1960 x 1897 pixels.
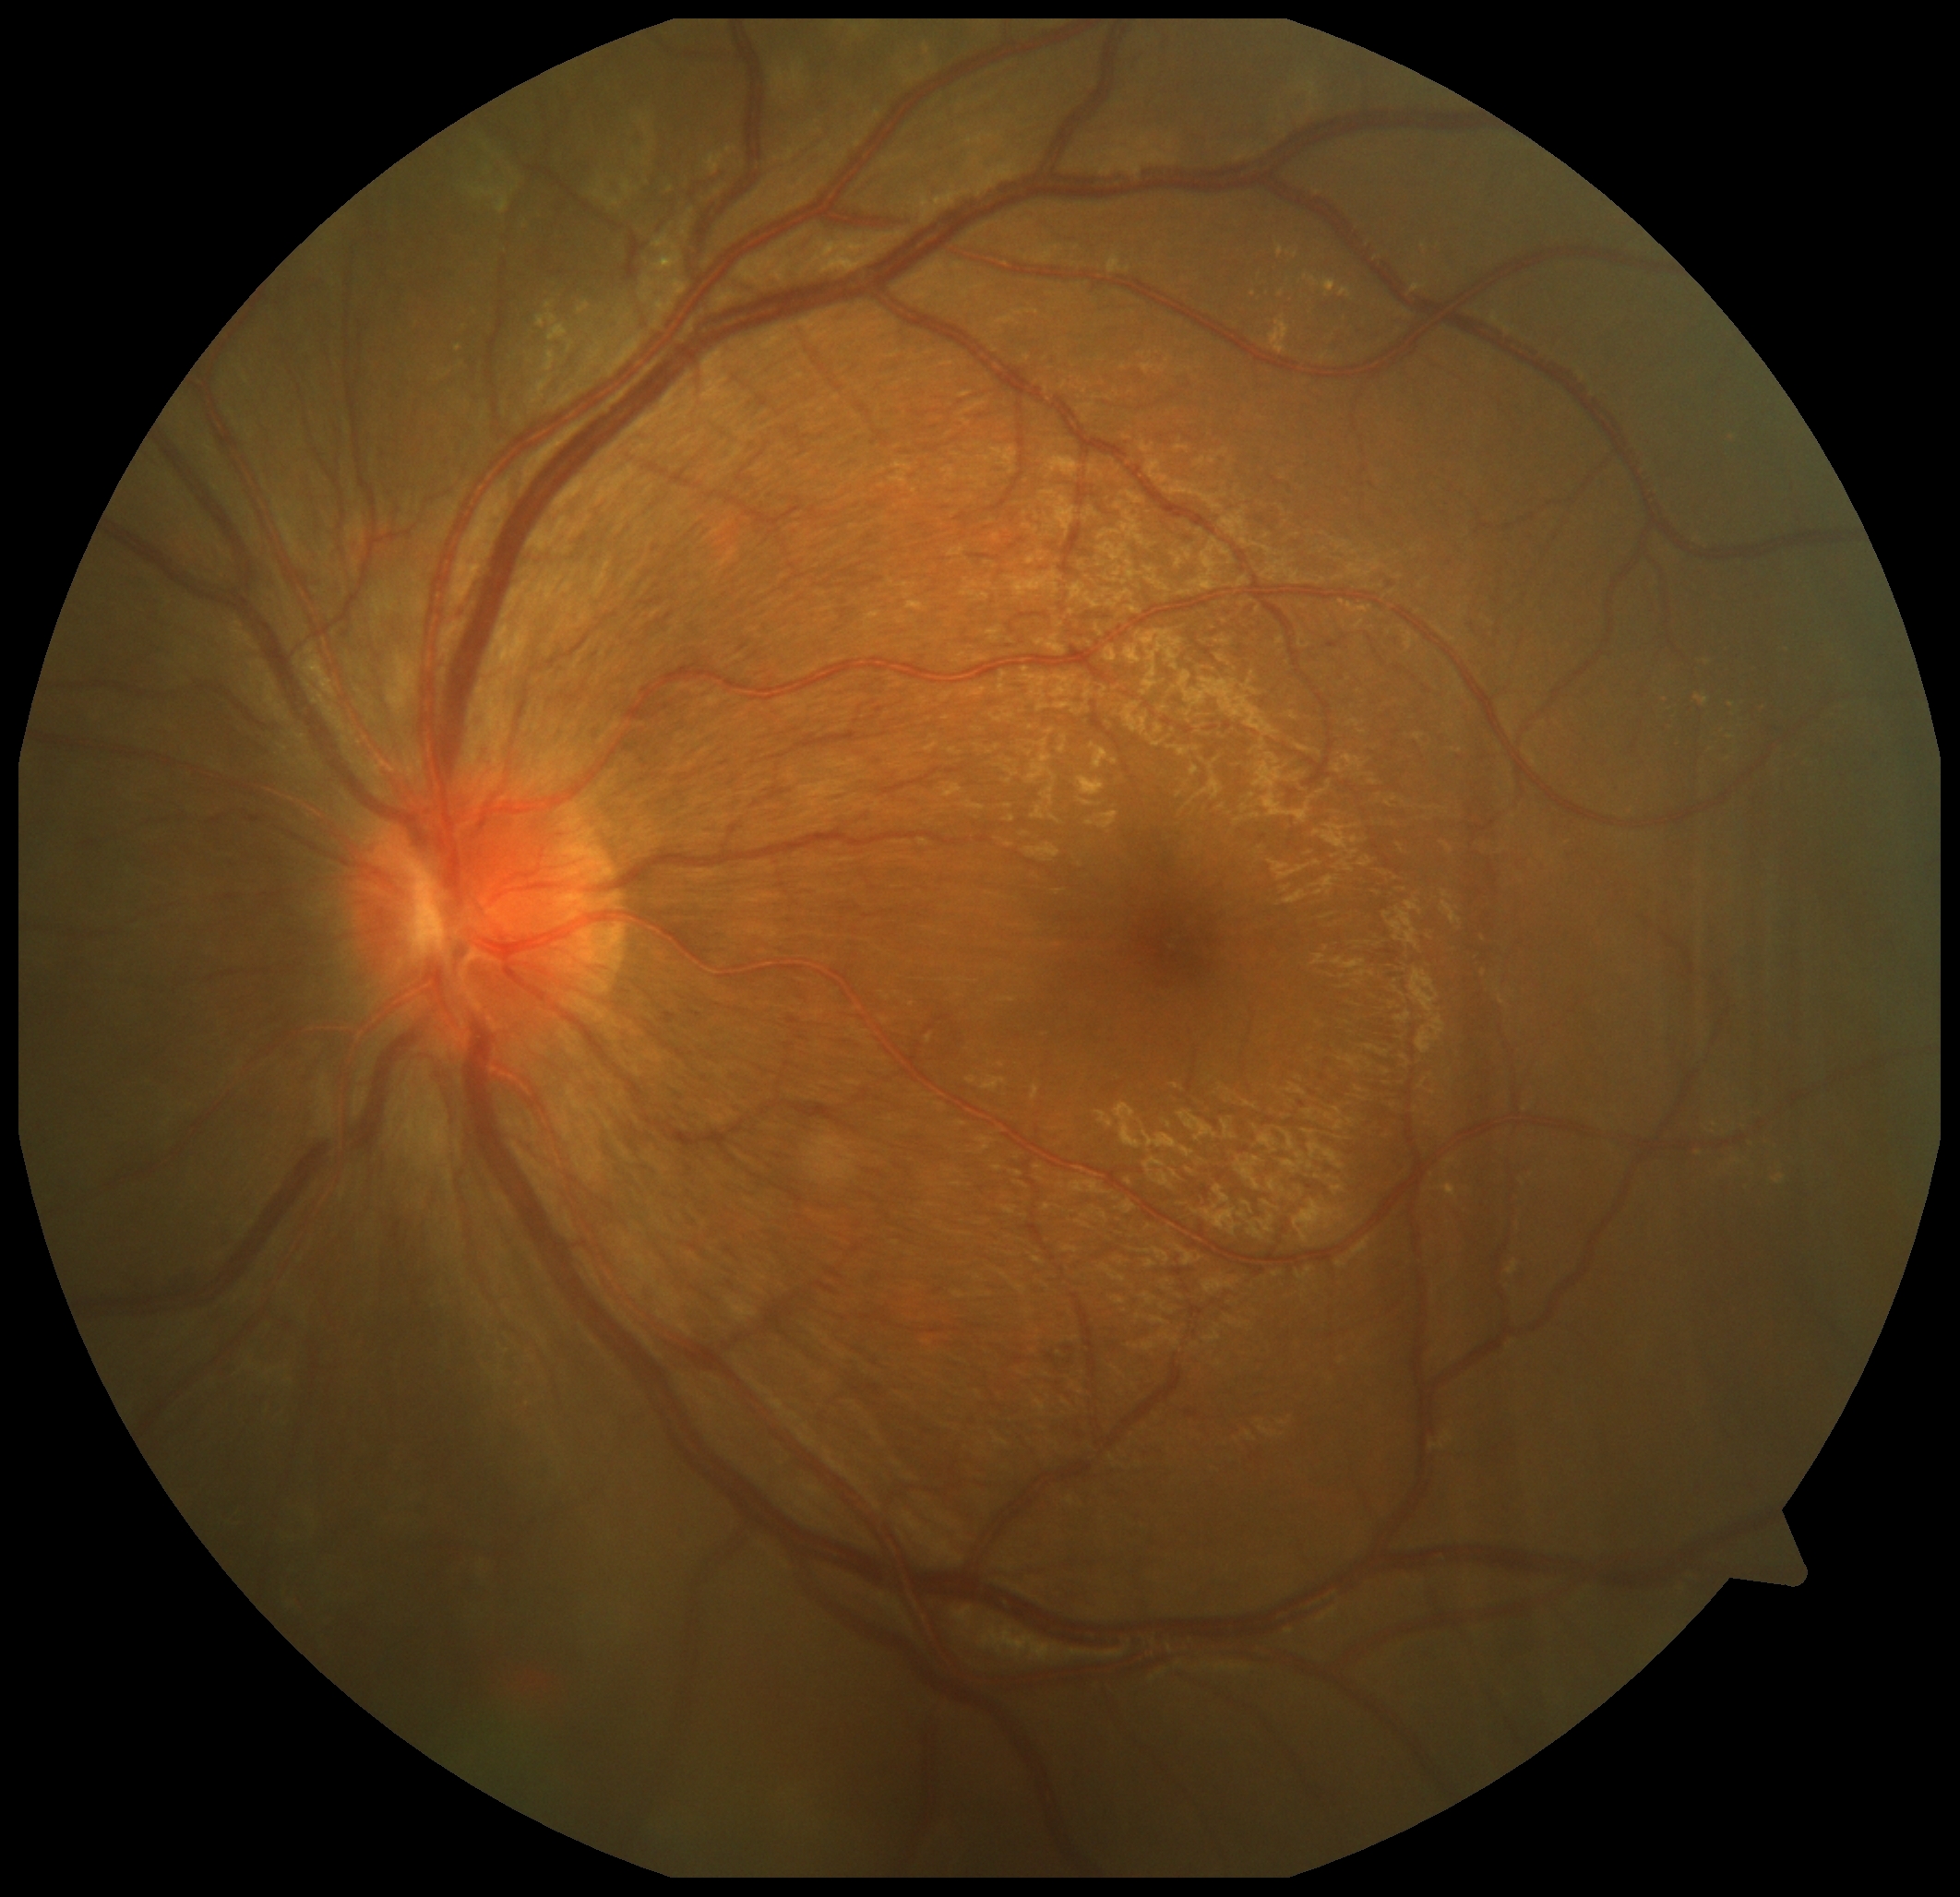 Annotations:
* diabetic retinopathy (DR) — 2